45° FOV. Color fundus image — 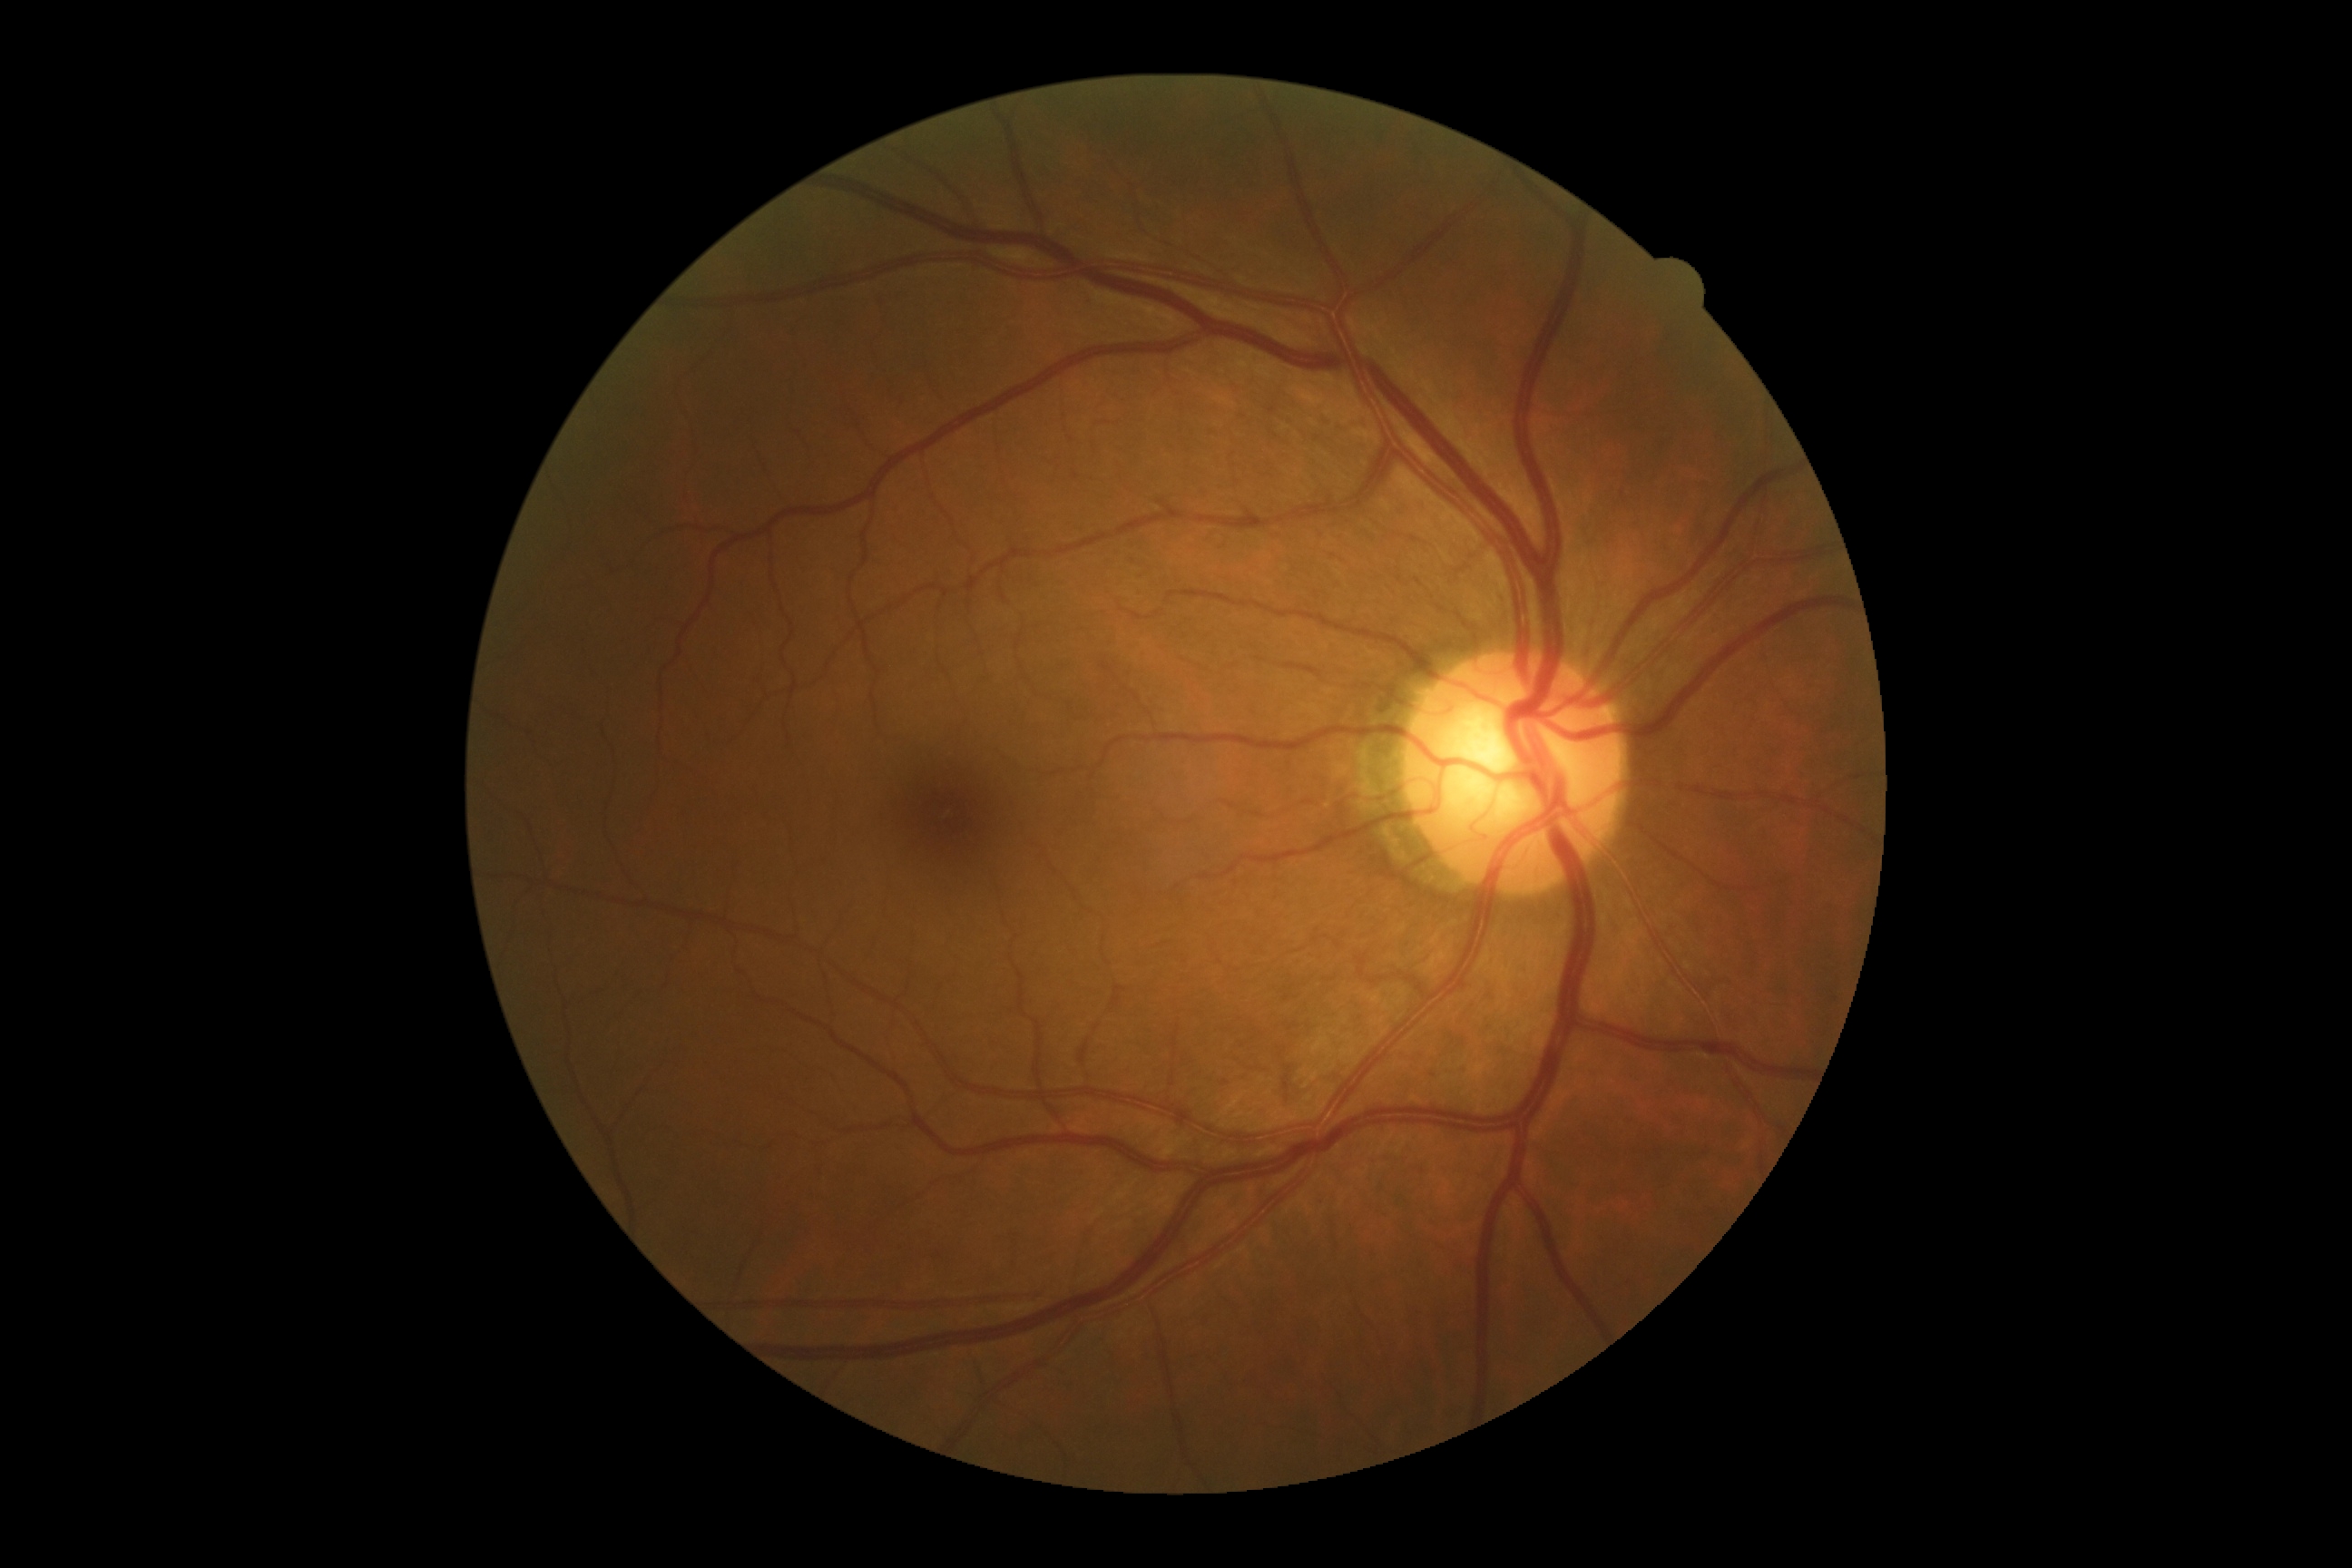

No apparent diabetic retinopathy. DR grade: 0/4.